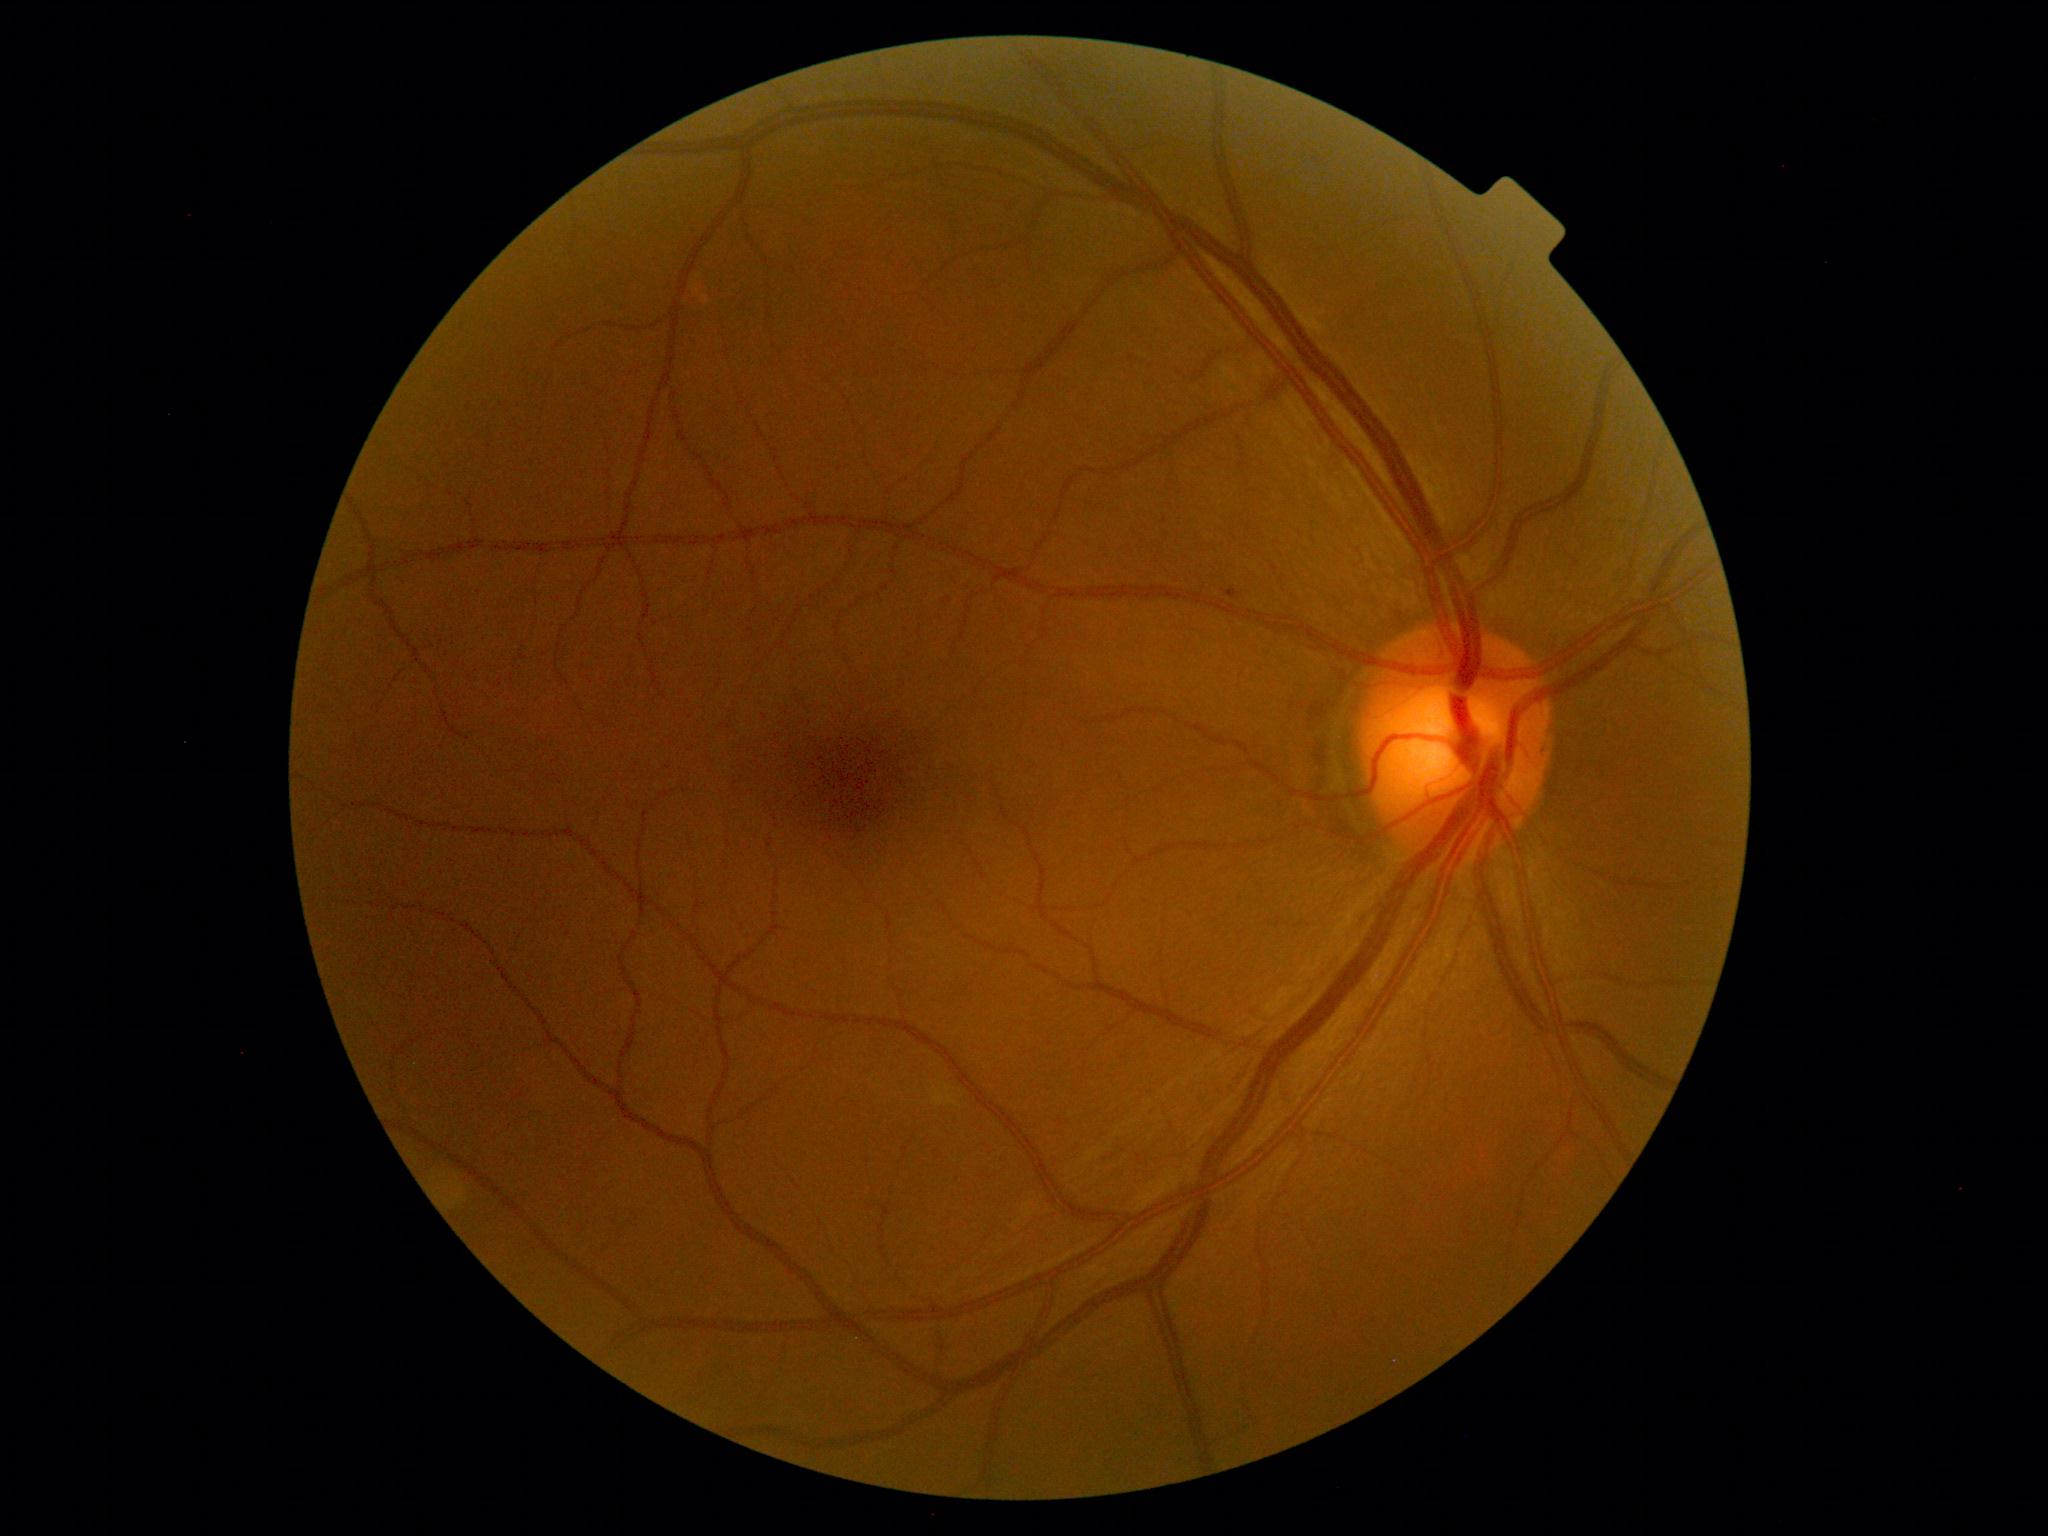 Diabetic retinopathy is 1/4.